DR severity per modified Davis staging — 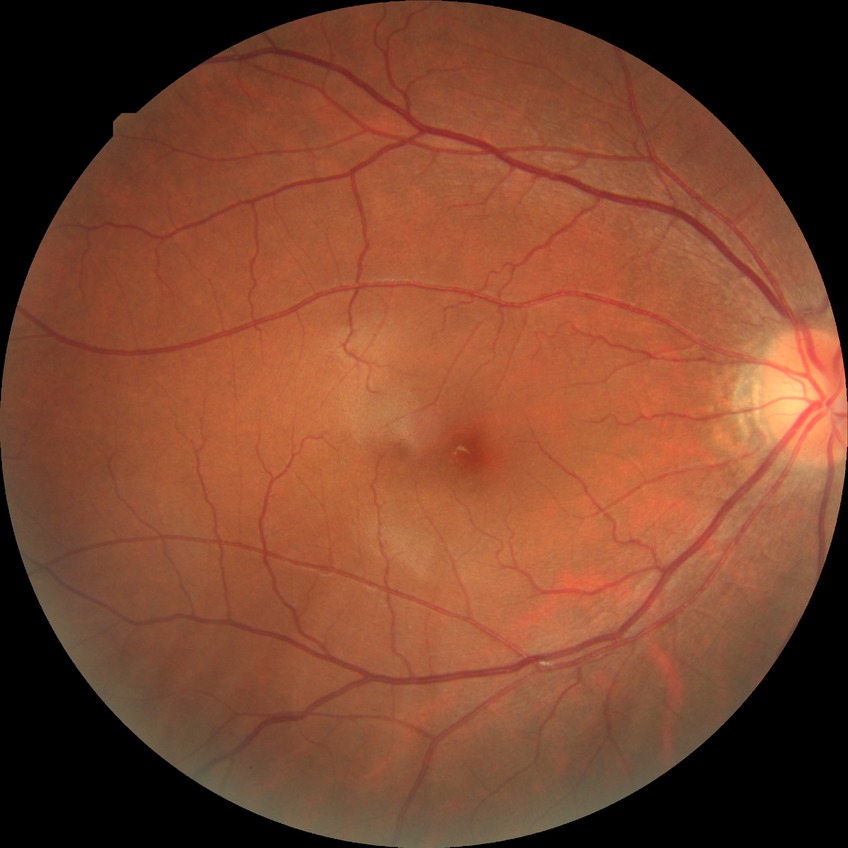 {
  "davis_grade": "no diabetic retinopathy"
}